2352x1568px
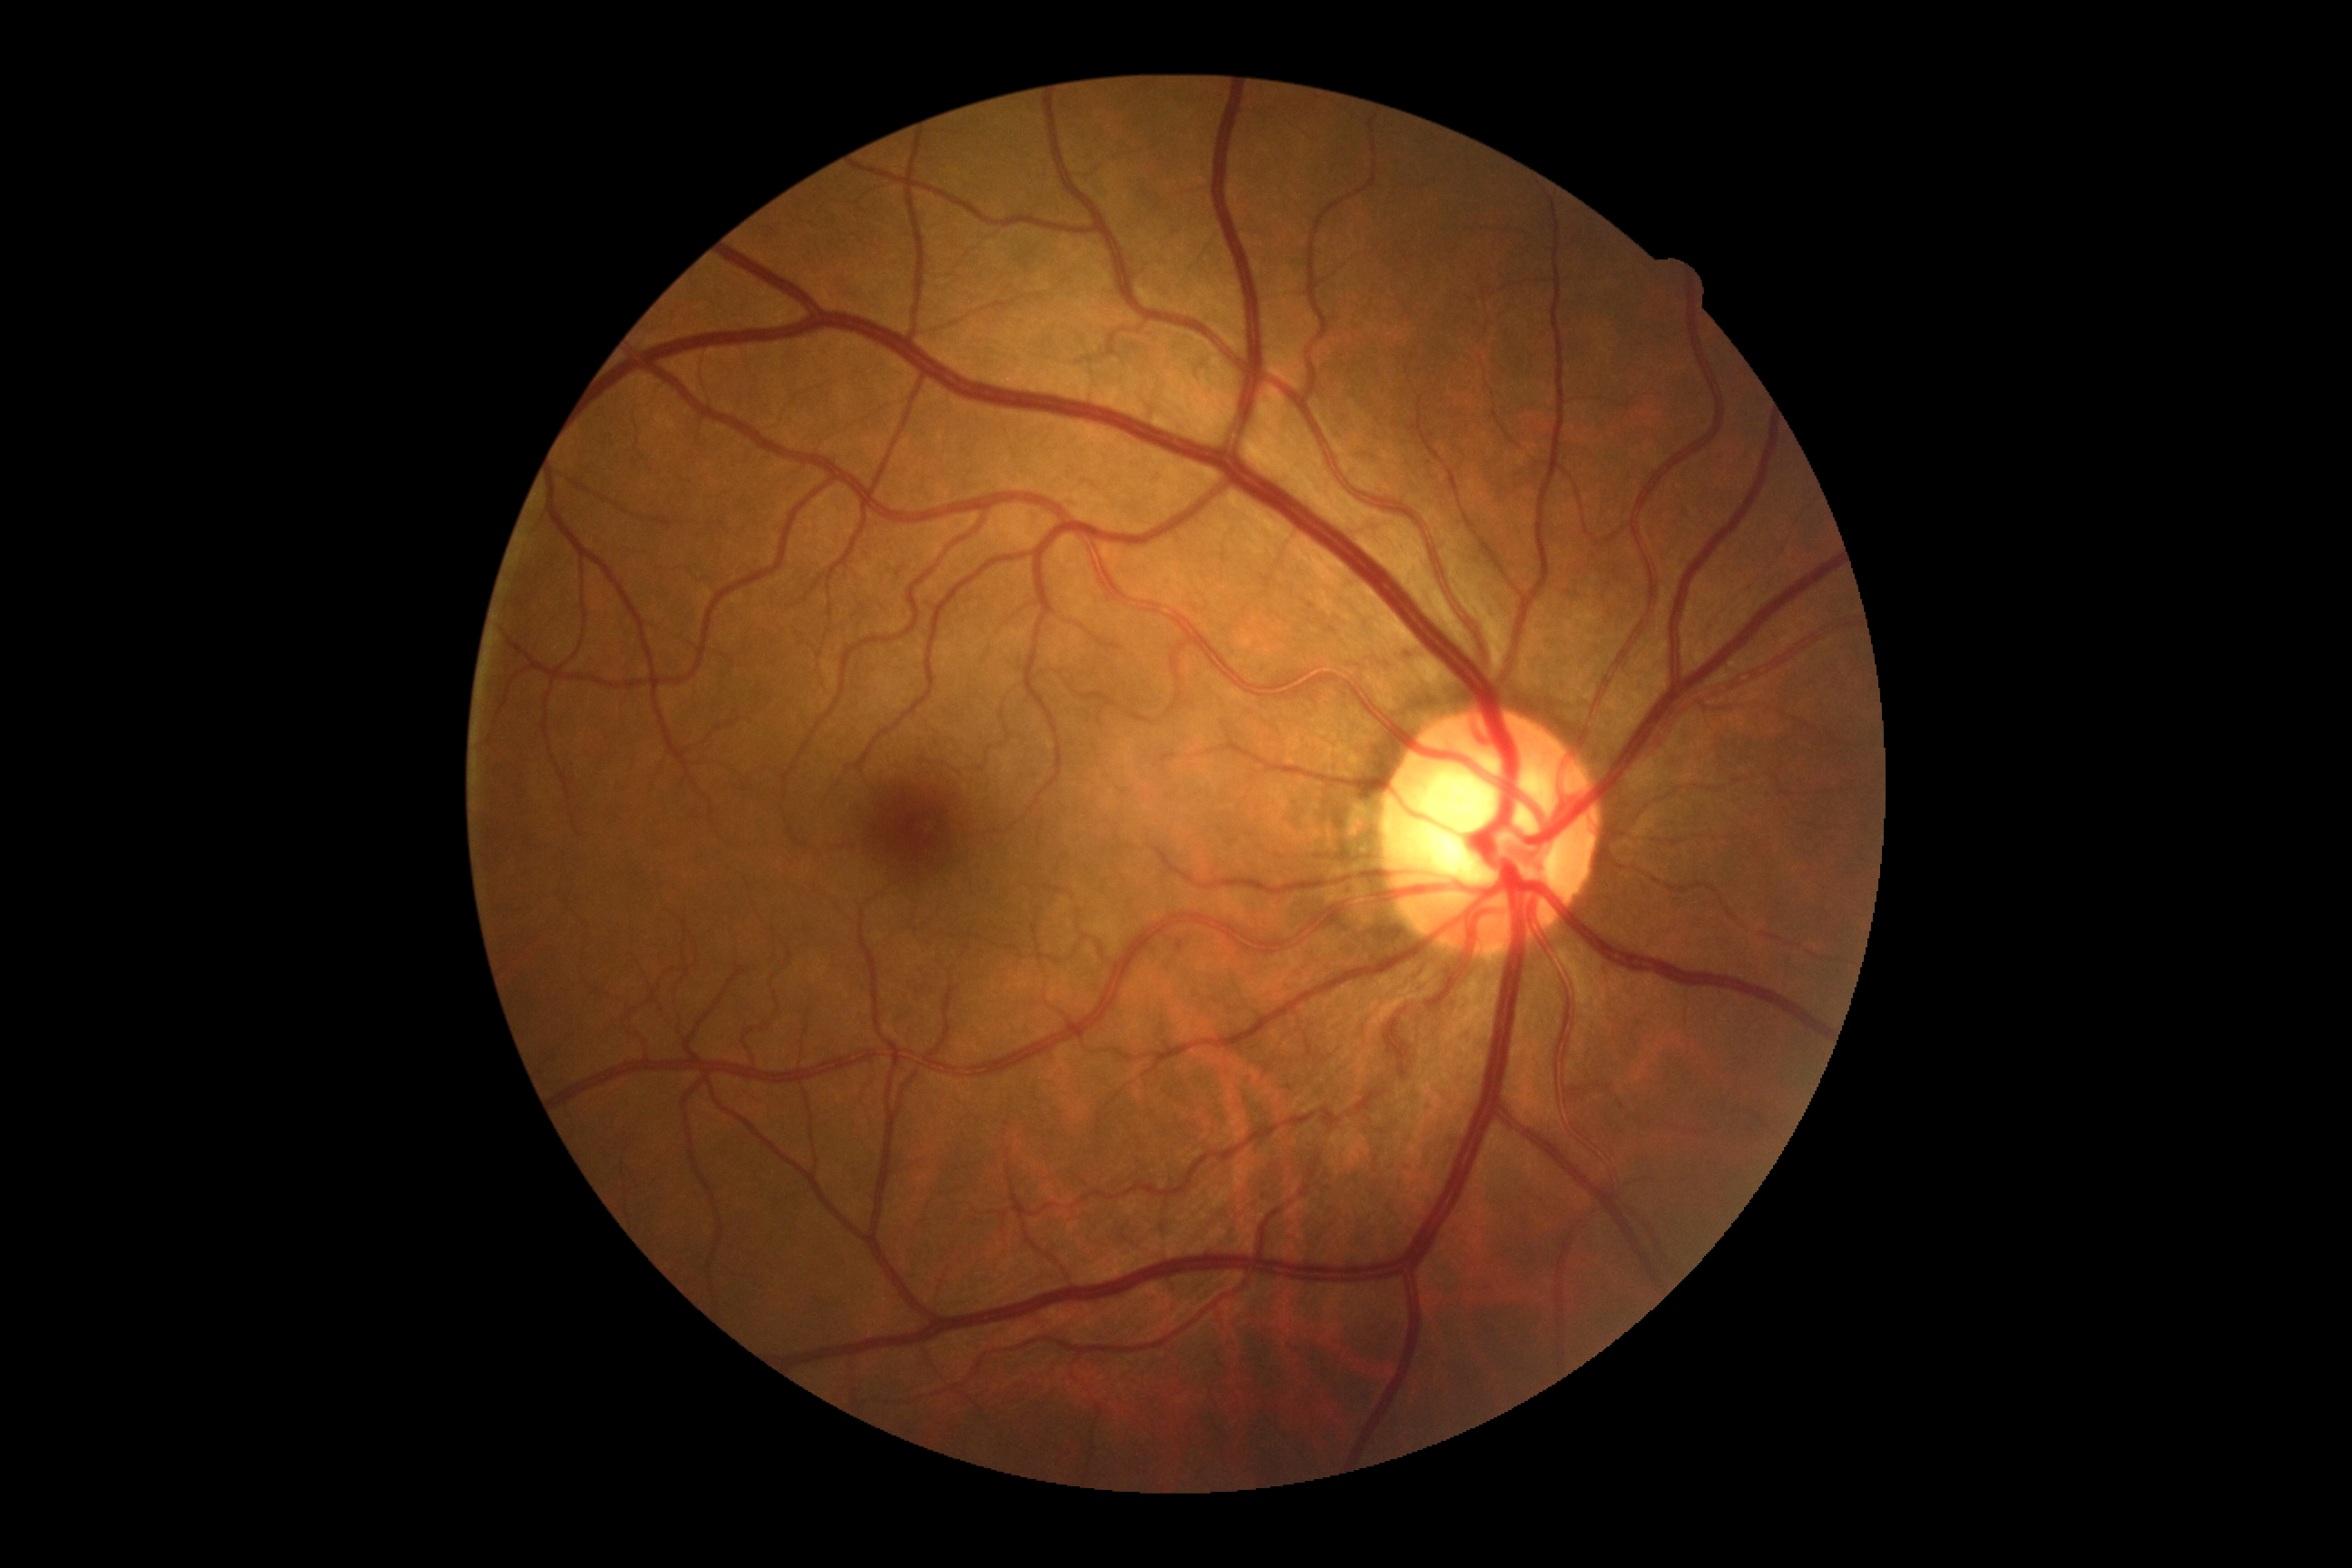

No signs of diabetic retinopathy. DR grade: 0 (no apparent retinopathy).